2184 by 1690 pixels:
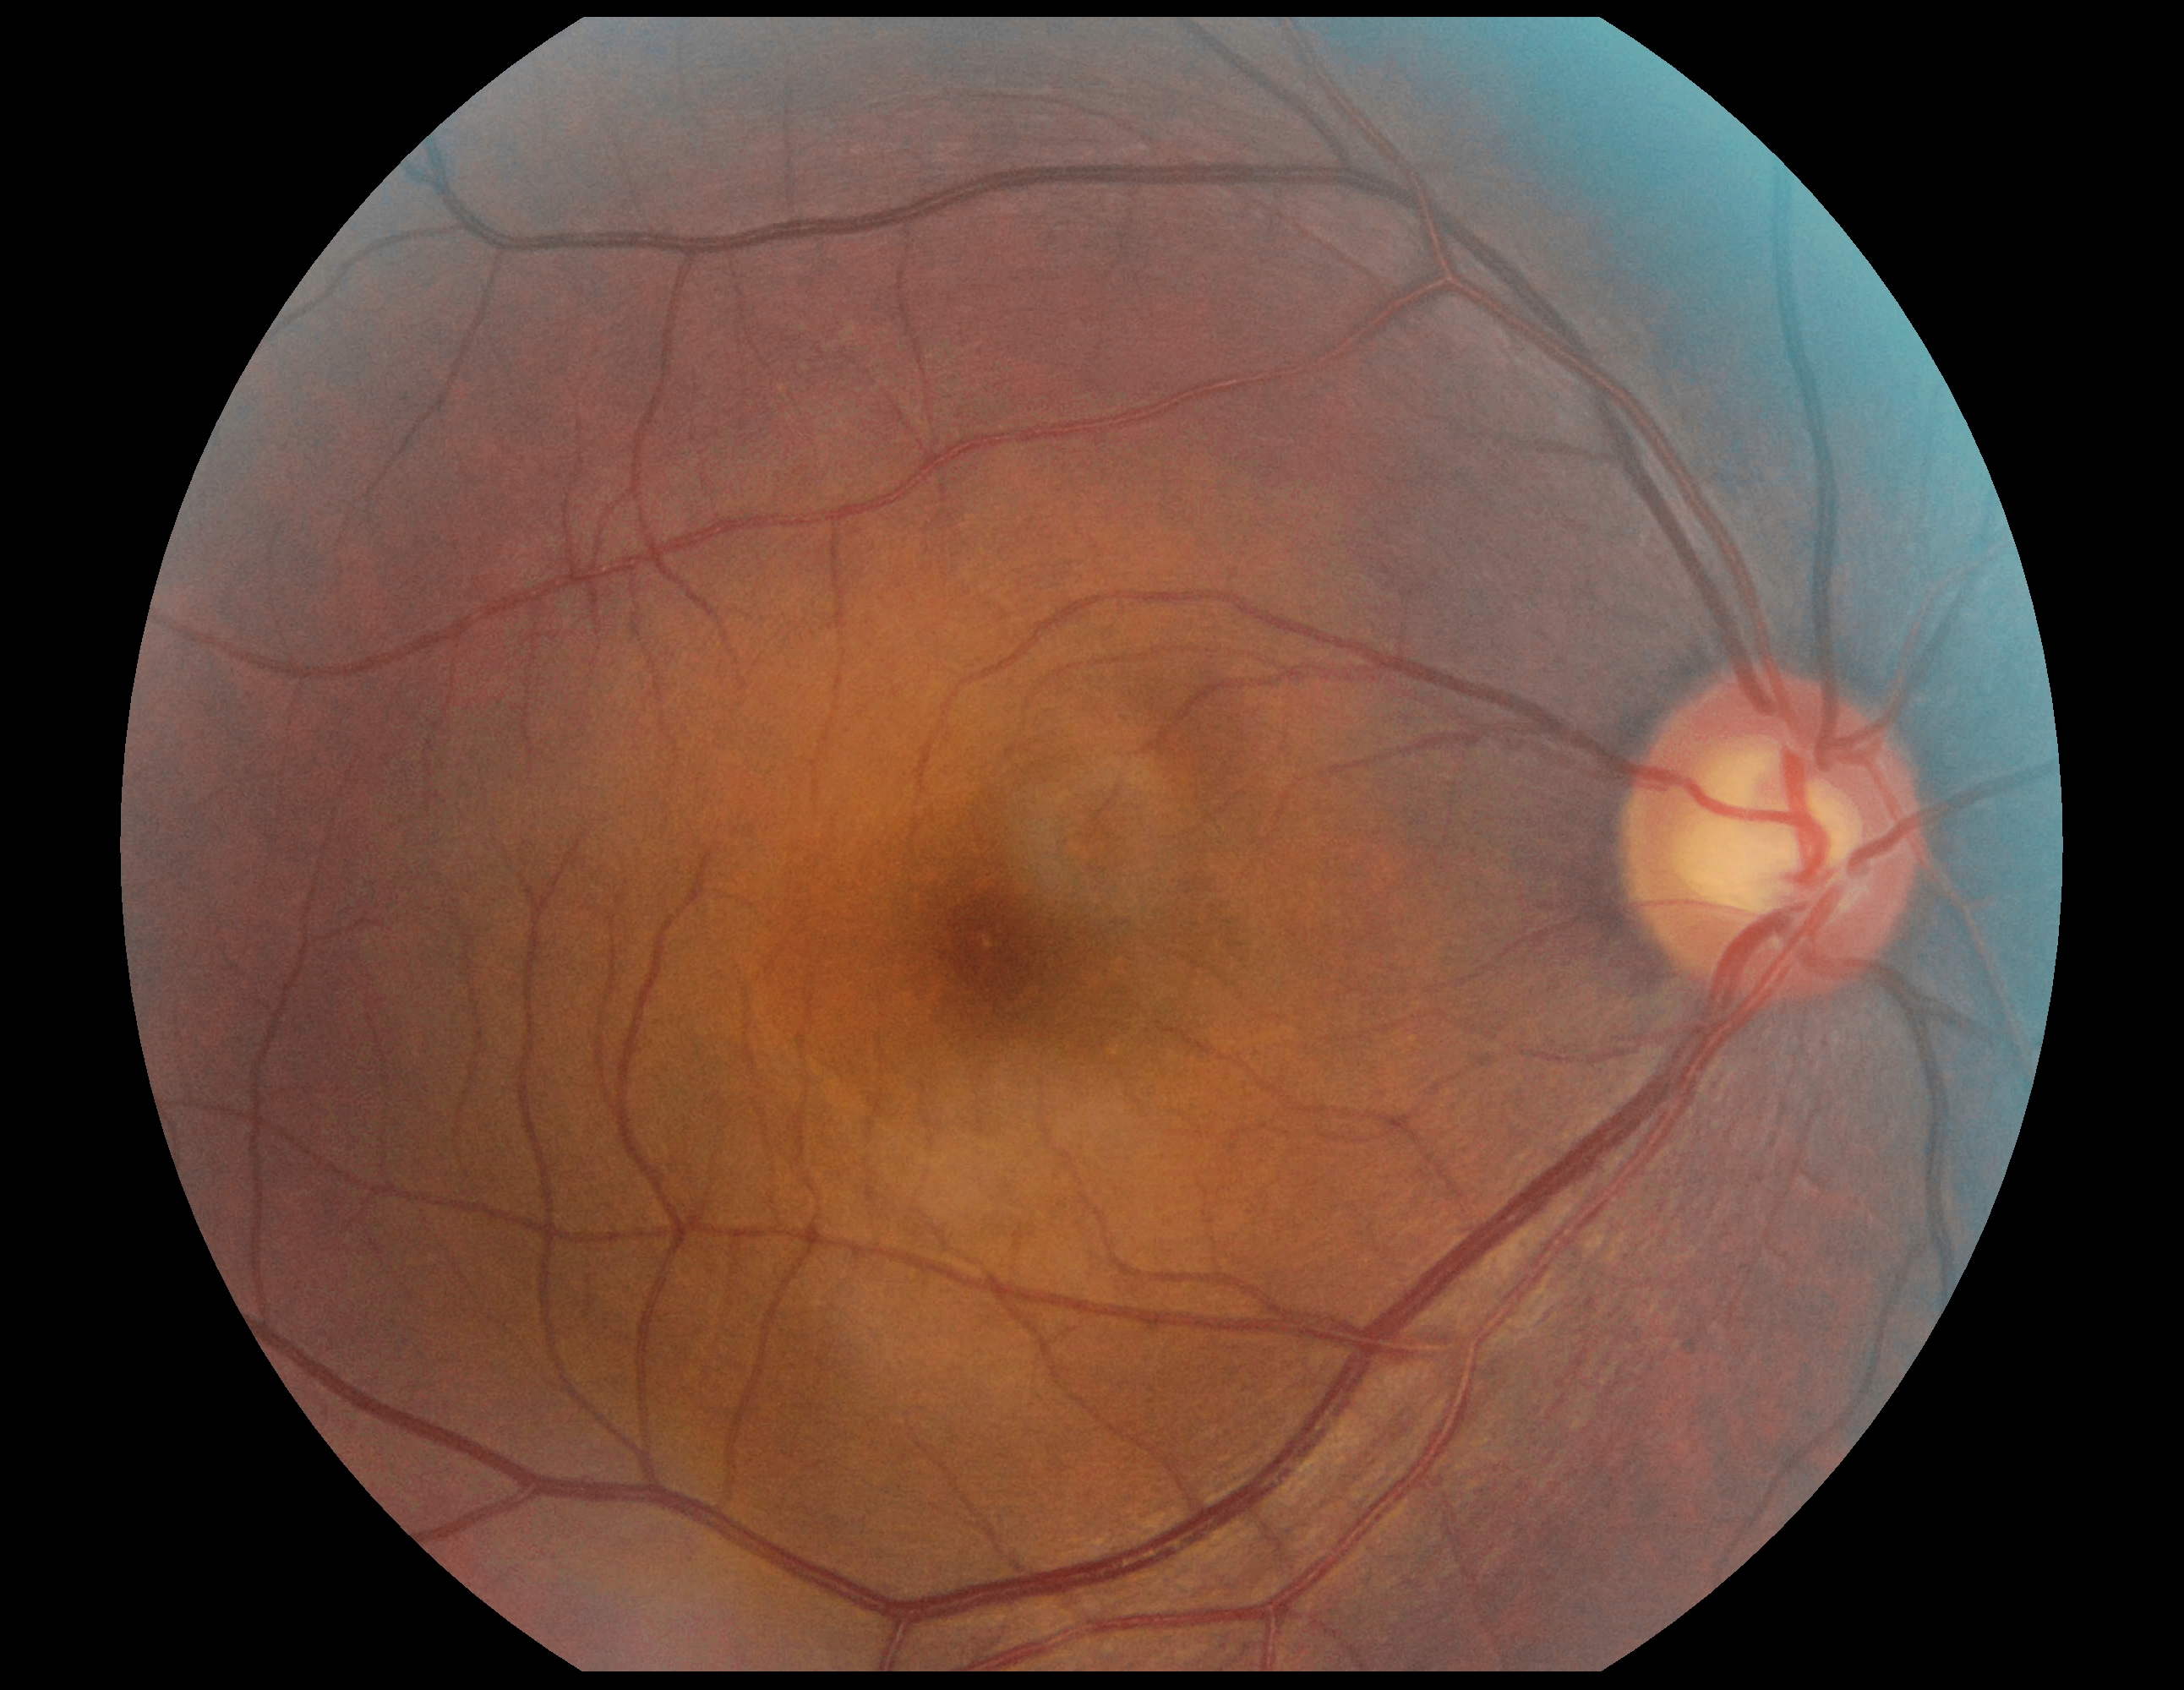

DR impression: negative for DR | DR severity: 0 — no visible signs of diabetic retinopathy.